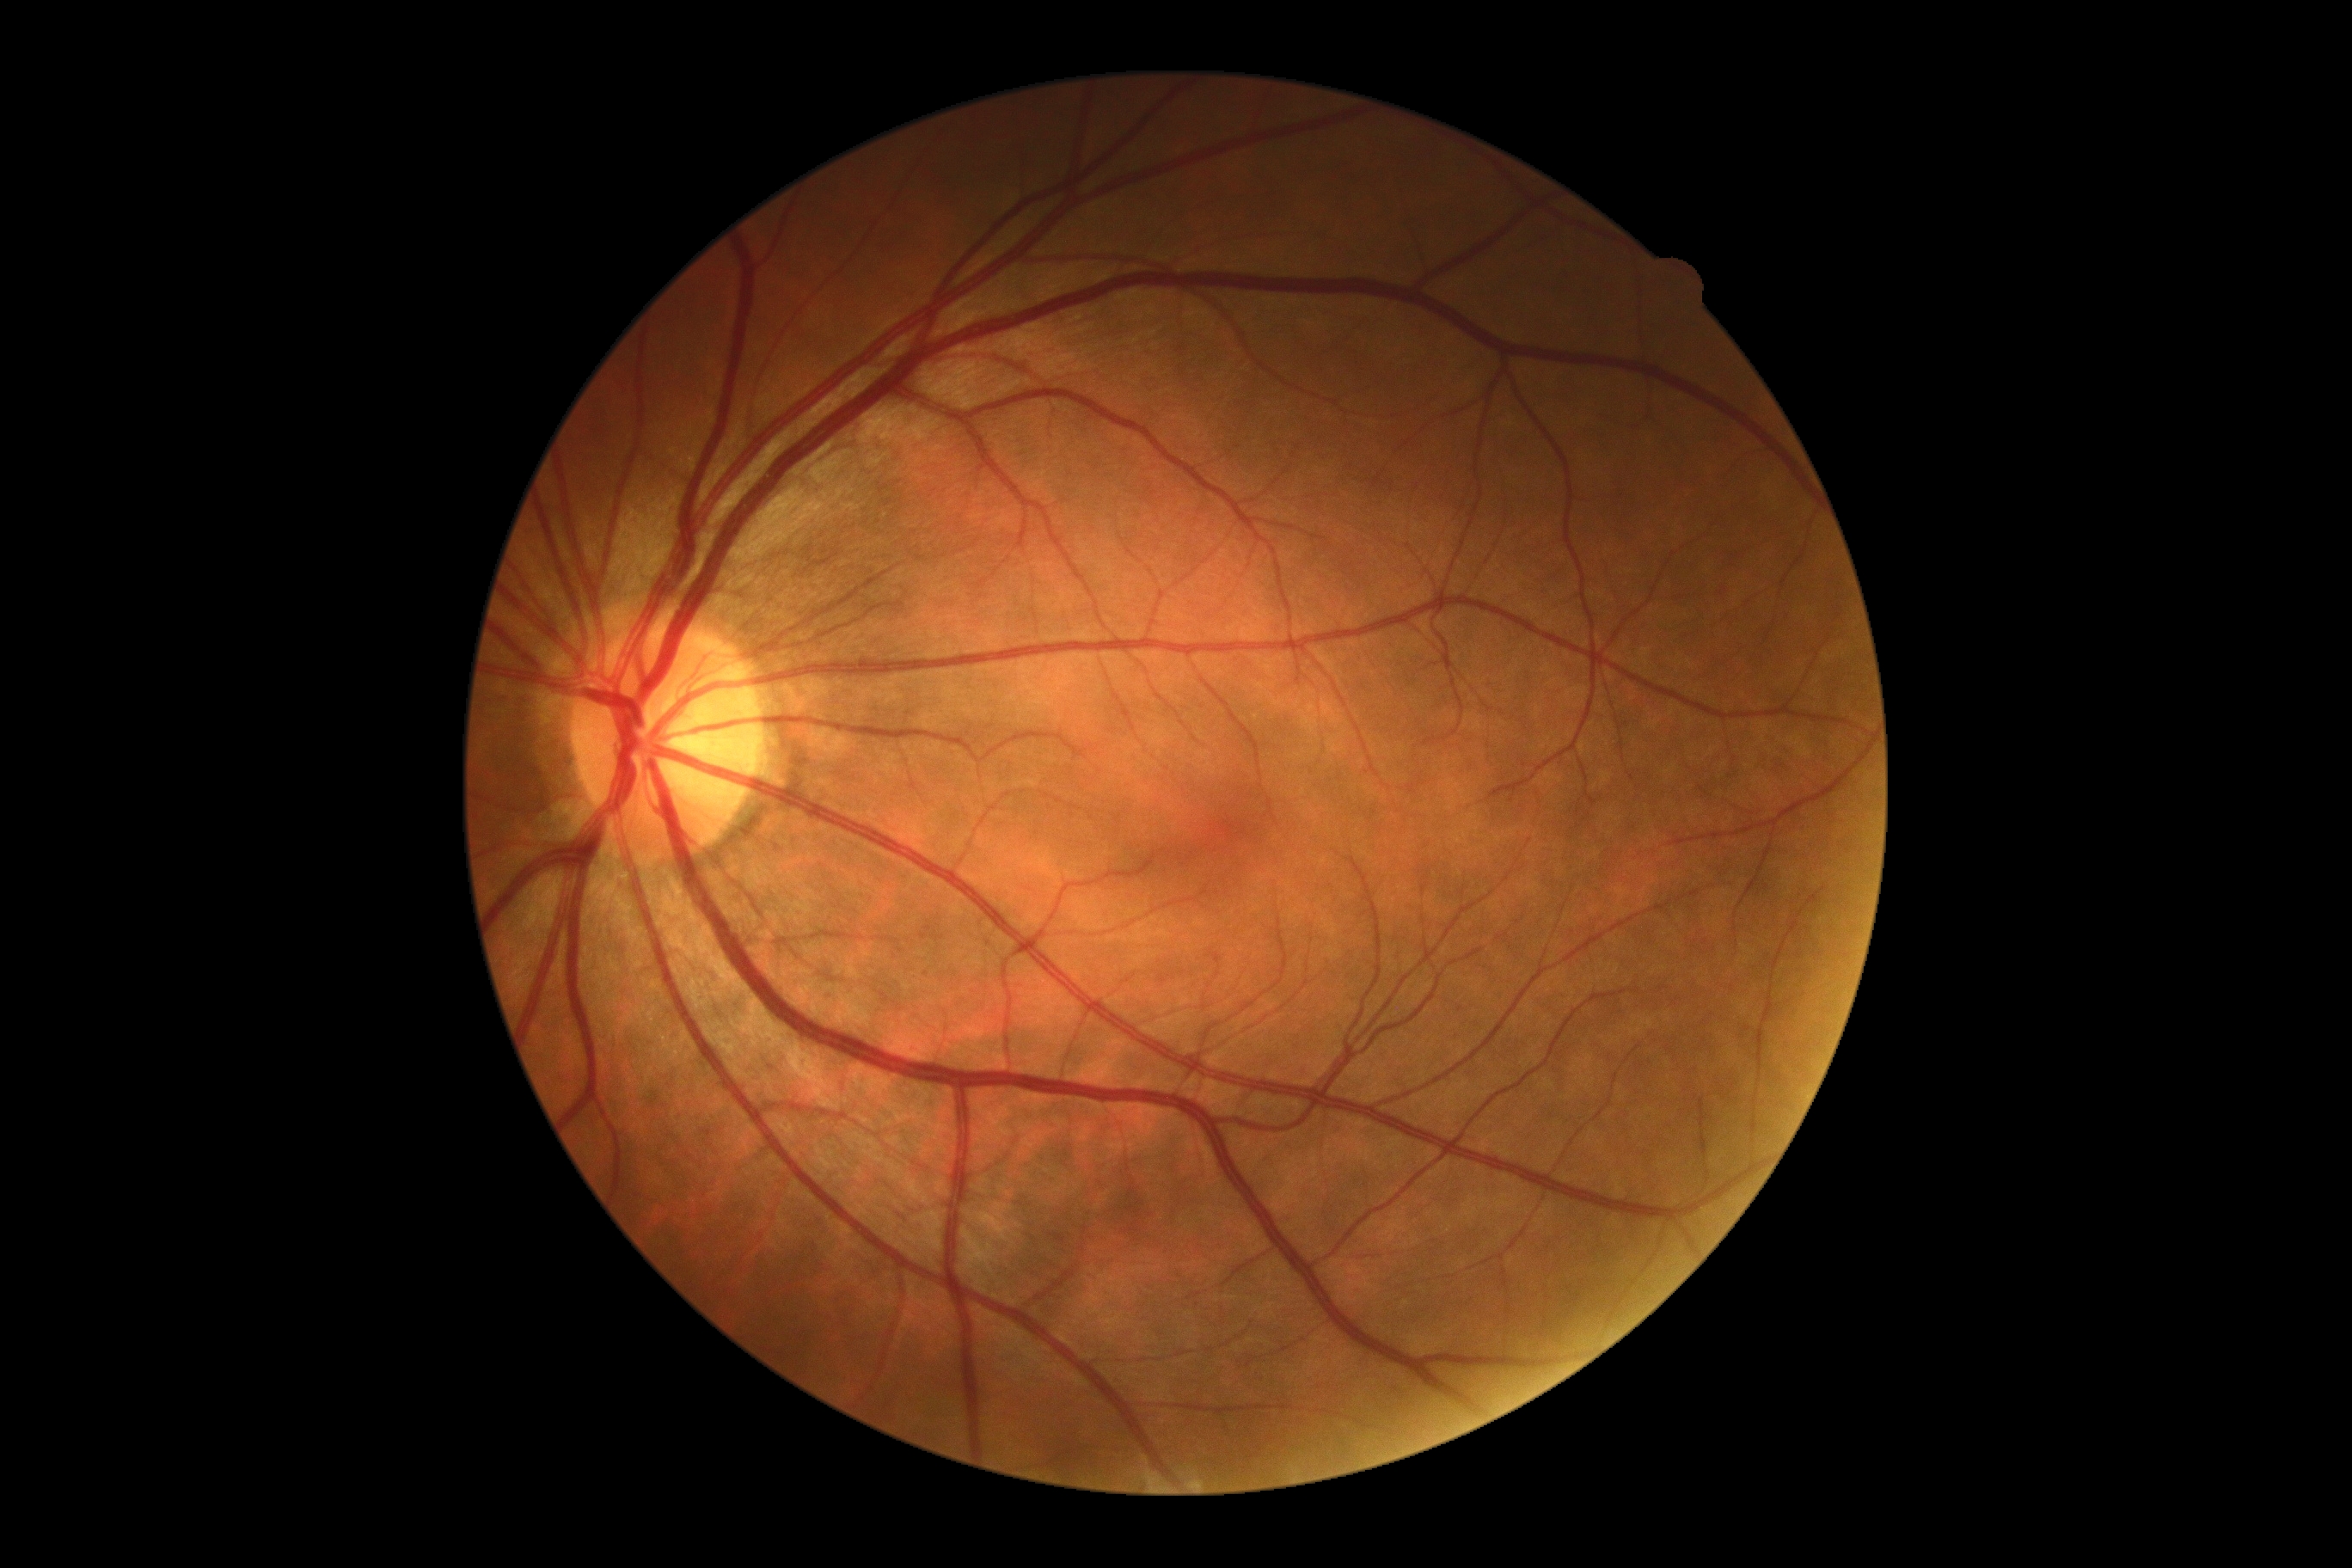

No DR findings.
Diabetic retinopathy (DR) is grade 0 (no apparent retinopathy) — no visible signs of diabetic retinopathy.